Wide-field fundus image from infant ROP screening — 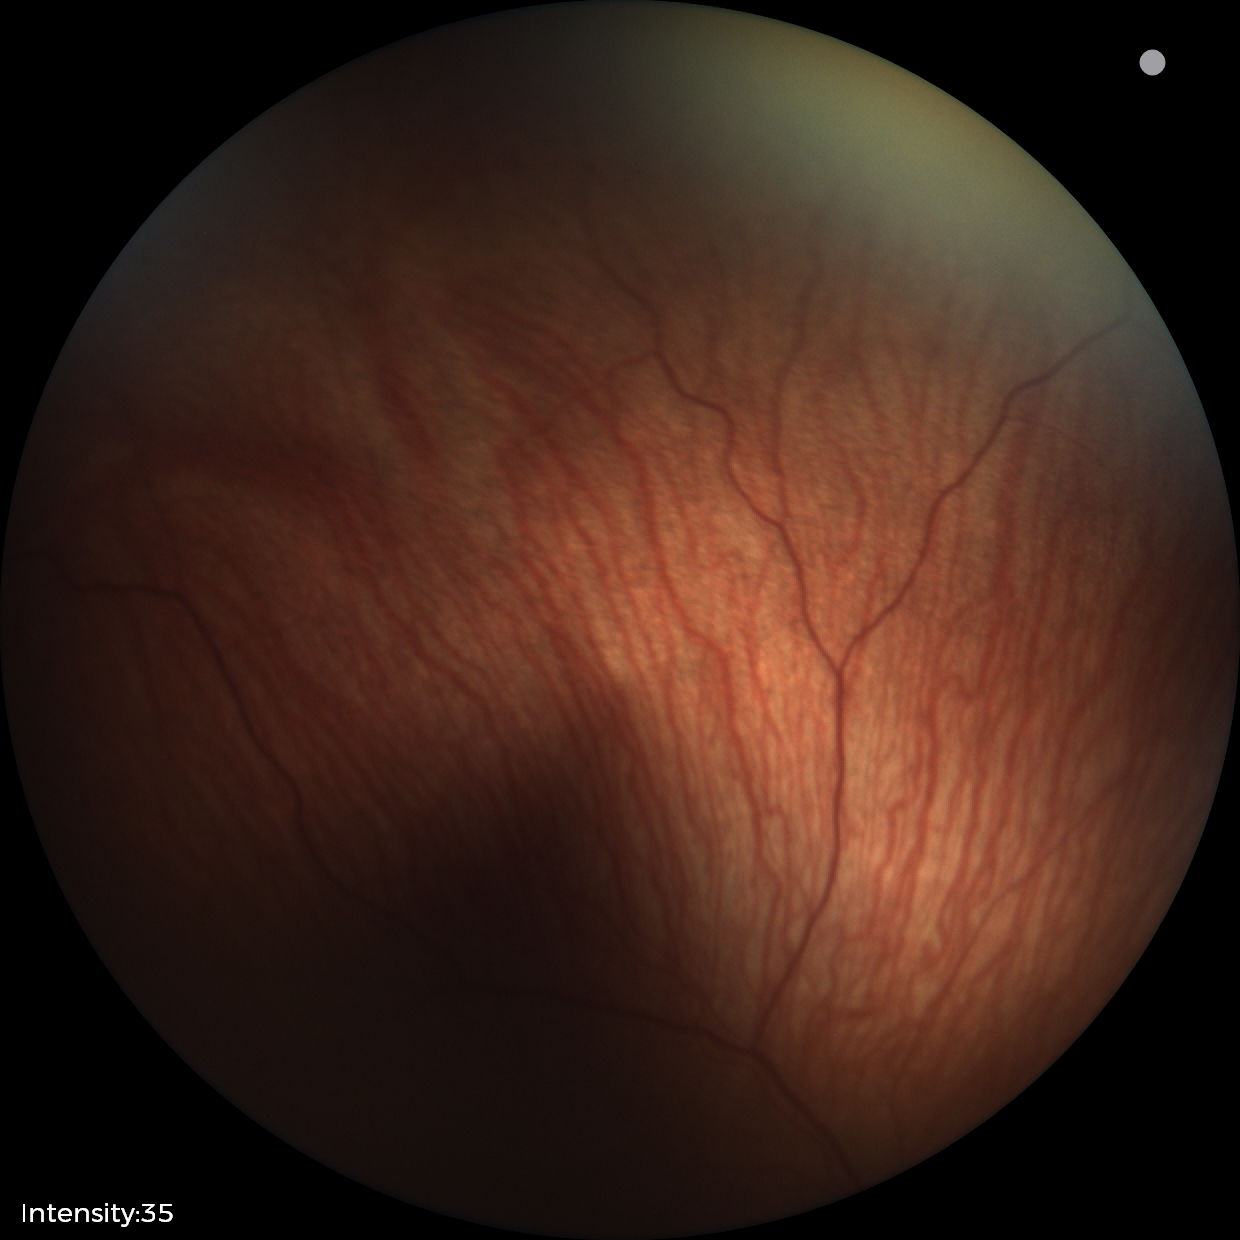

Plus disease: absent | finding: status post ROP.